Diabetic retinopathy graded by the modified Davis classification.
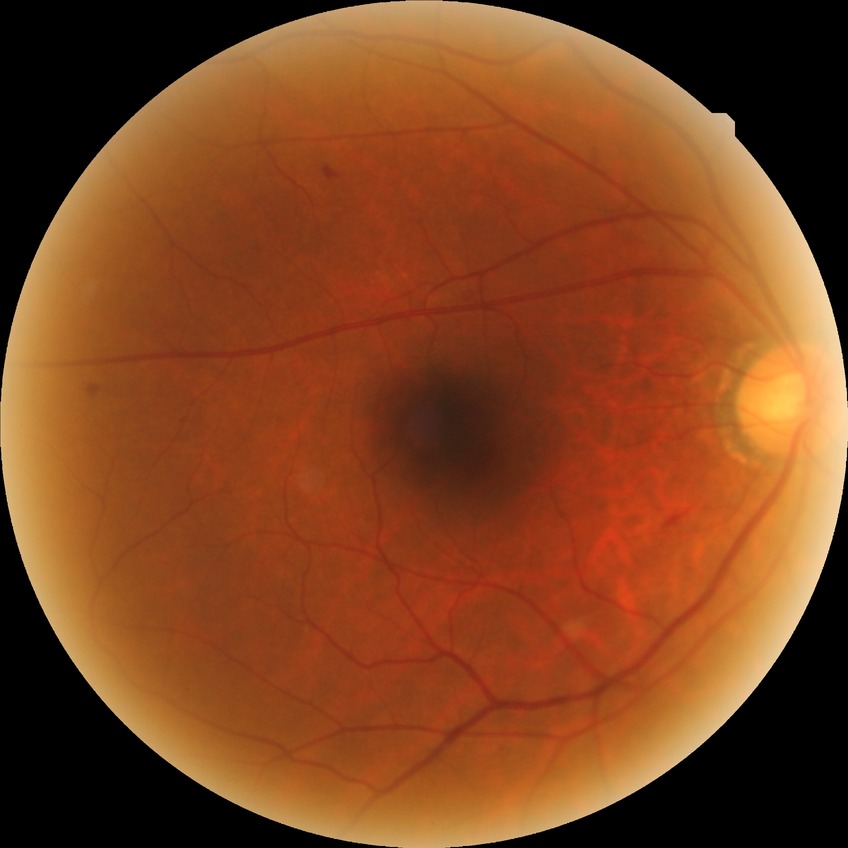 Retinopathy grade: simple diabetic retinopathy. The retinopathy is classified as non-proliferative diabetic retinopathy.